Nidek AFC-330
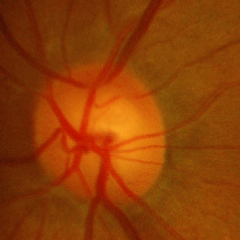
Findings consistent with glaucoma.
Early glaucoma.